Posterior pole color fundus photograph. Modified Davis grading. Acquired with a NIDEK AFC-230:
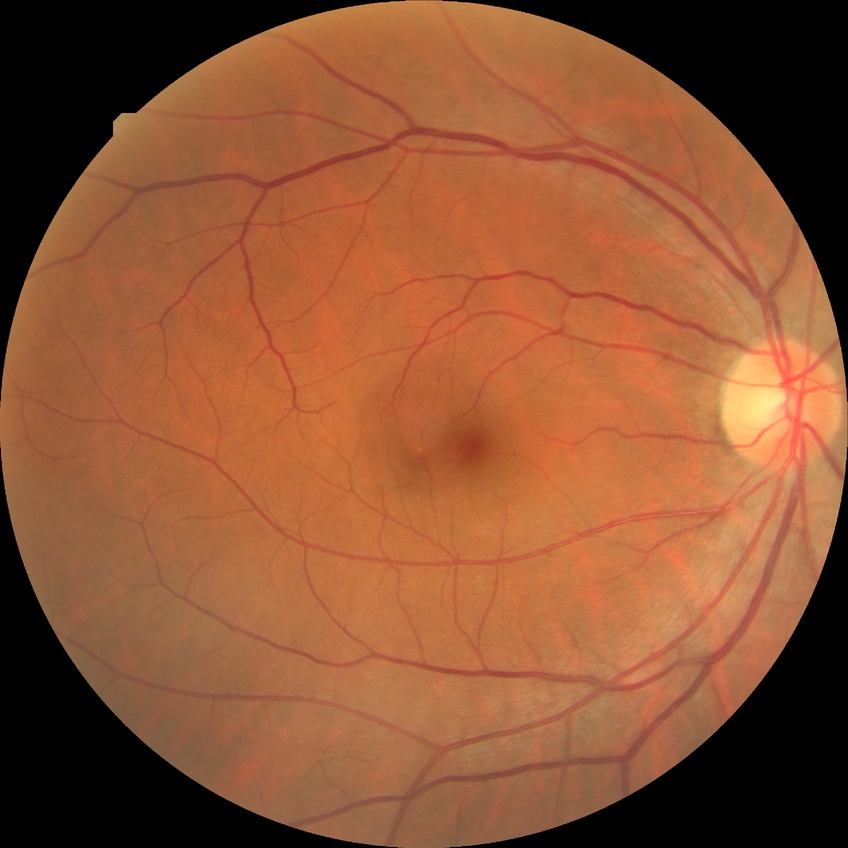
Annotations:
* diabetic retinopathy (DR) — no diabetic retinopathy (NDR)